100° field of view (Phoenix ICON). Wide-field fundus image from infant ROP screening.
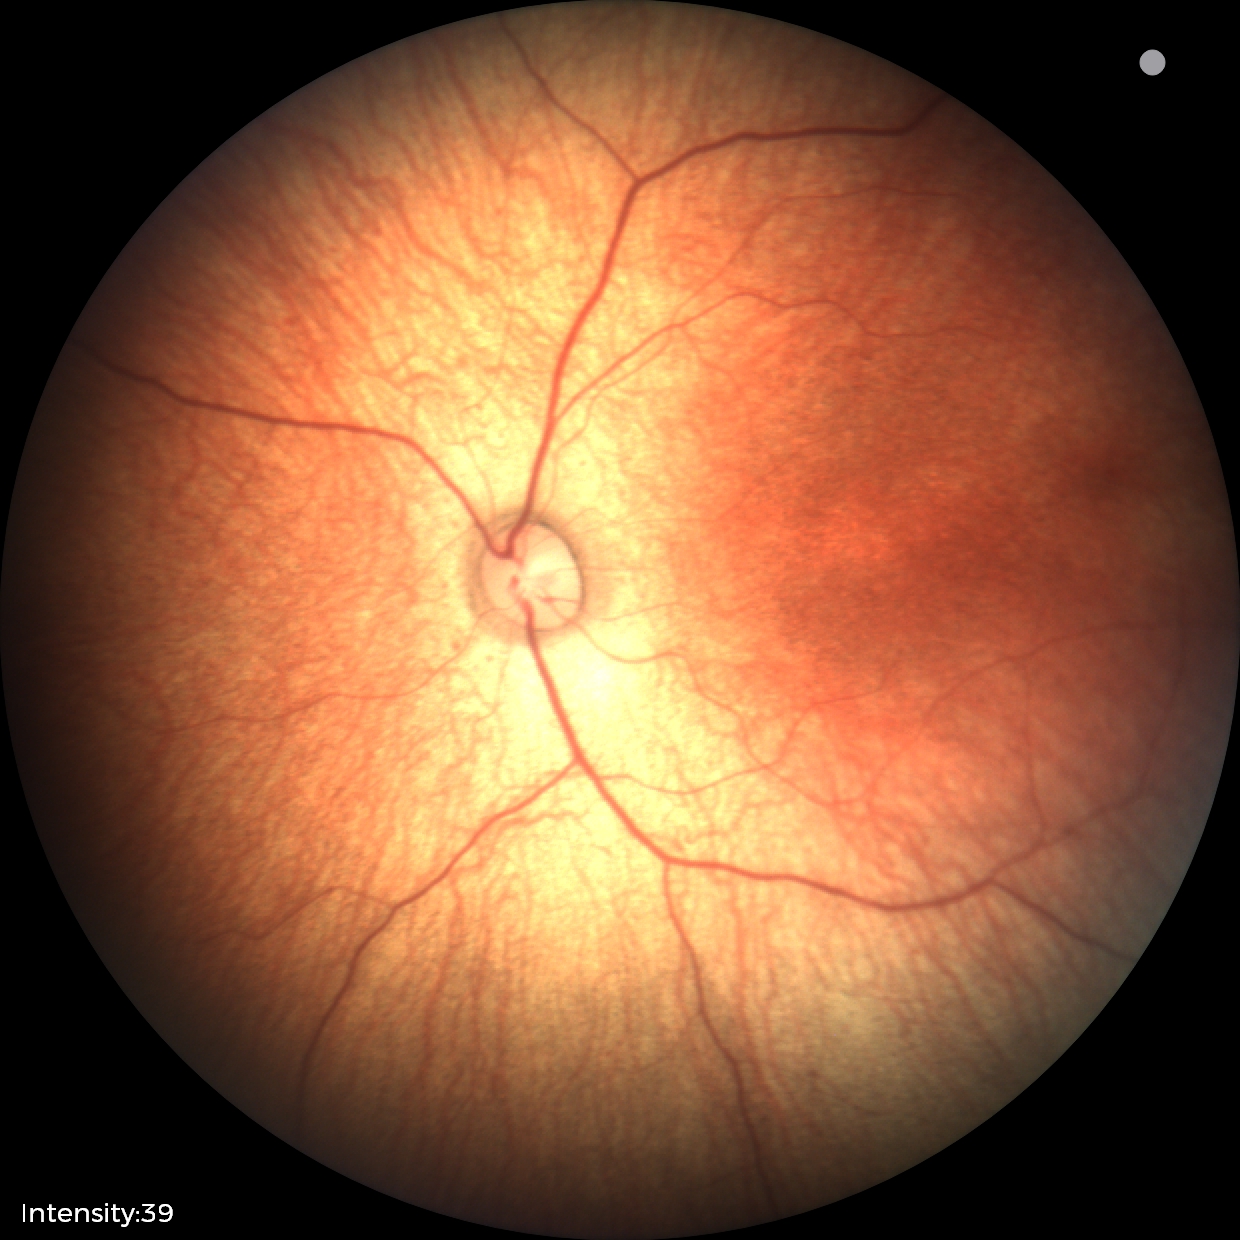 Examination with physiological retinal findings.